Nonmydriatic, 848 x 848 pixels, fundus photo, diabetic retinopathy graded by the modified Davis classification: 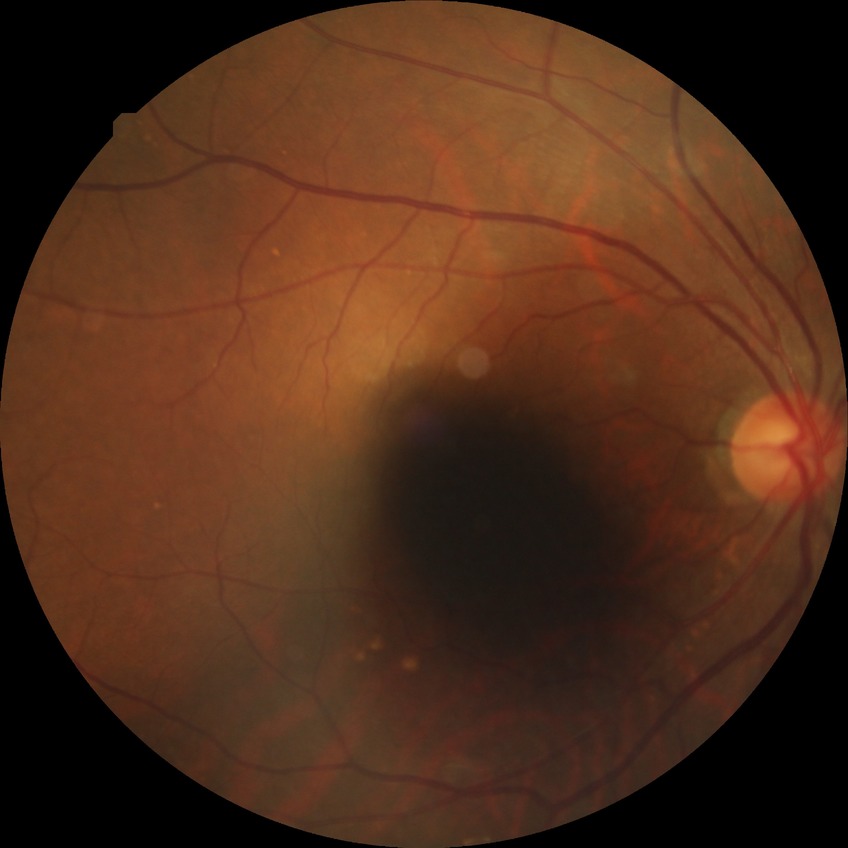 DR class = non-proliferative diabetic retinopathy; diabetic retinopathy (DR) = simple diabetic retinopathy (SDR).